Camera: Topcon TRC-NW400 · non-mydriatic acquisition:
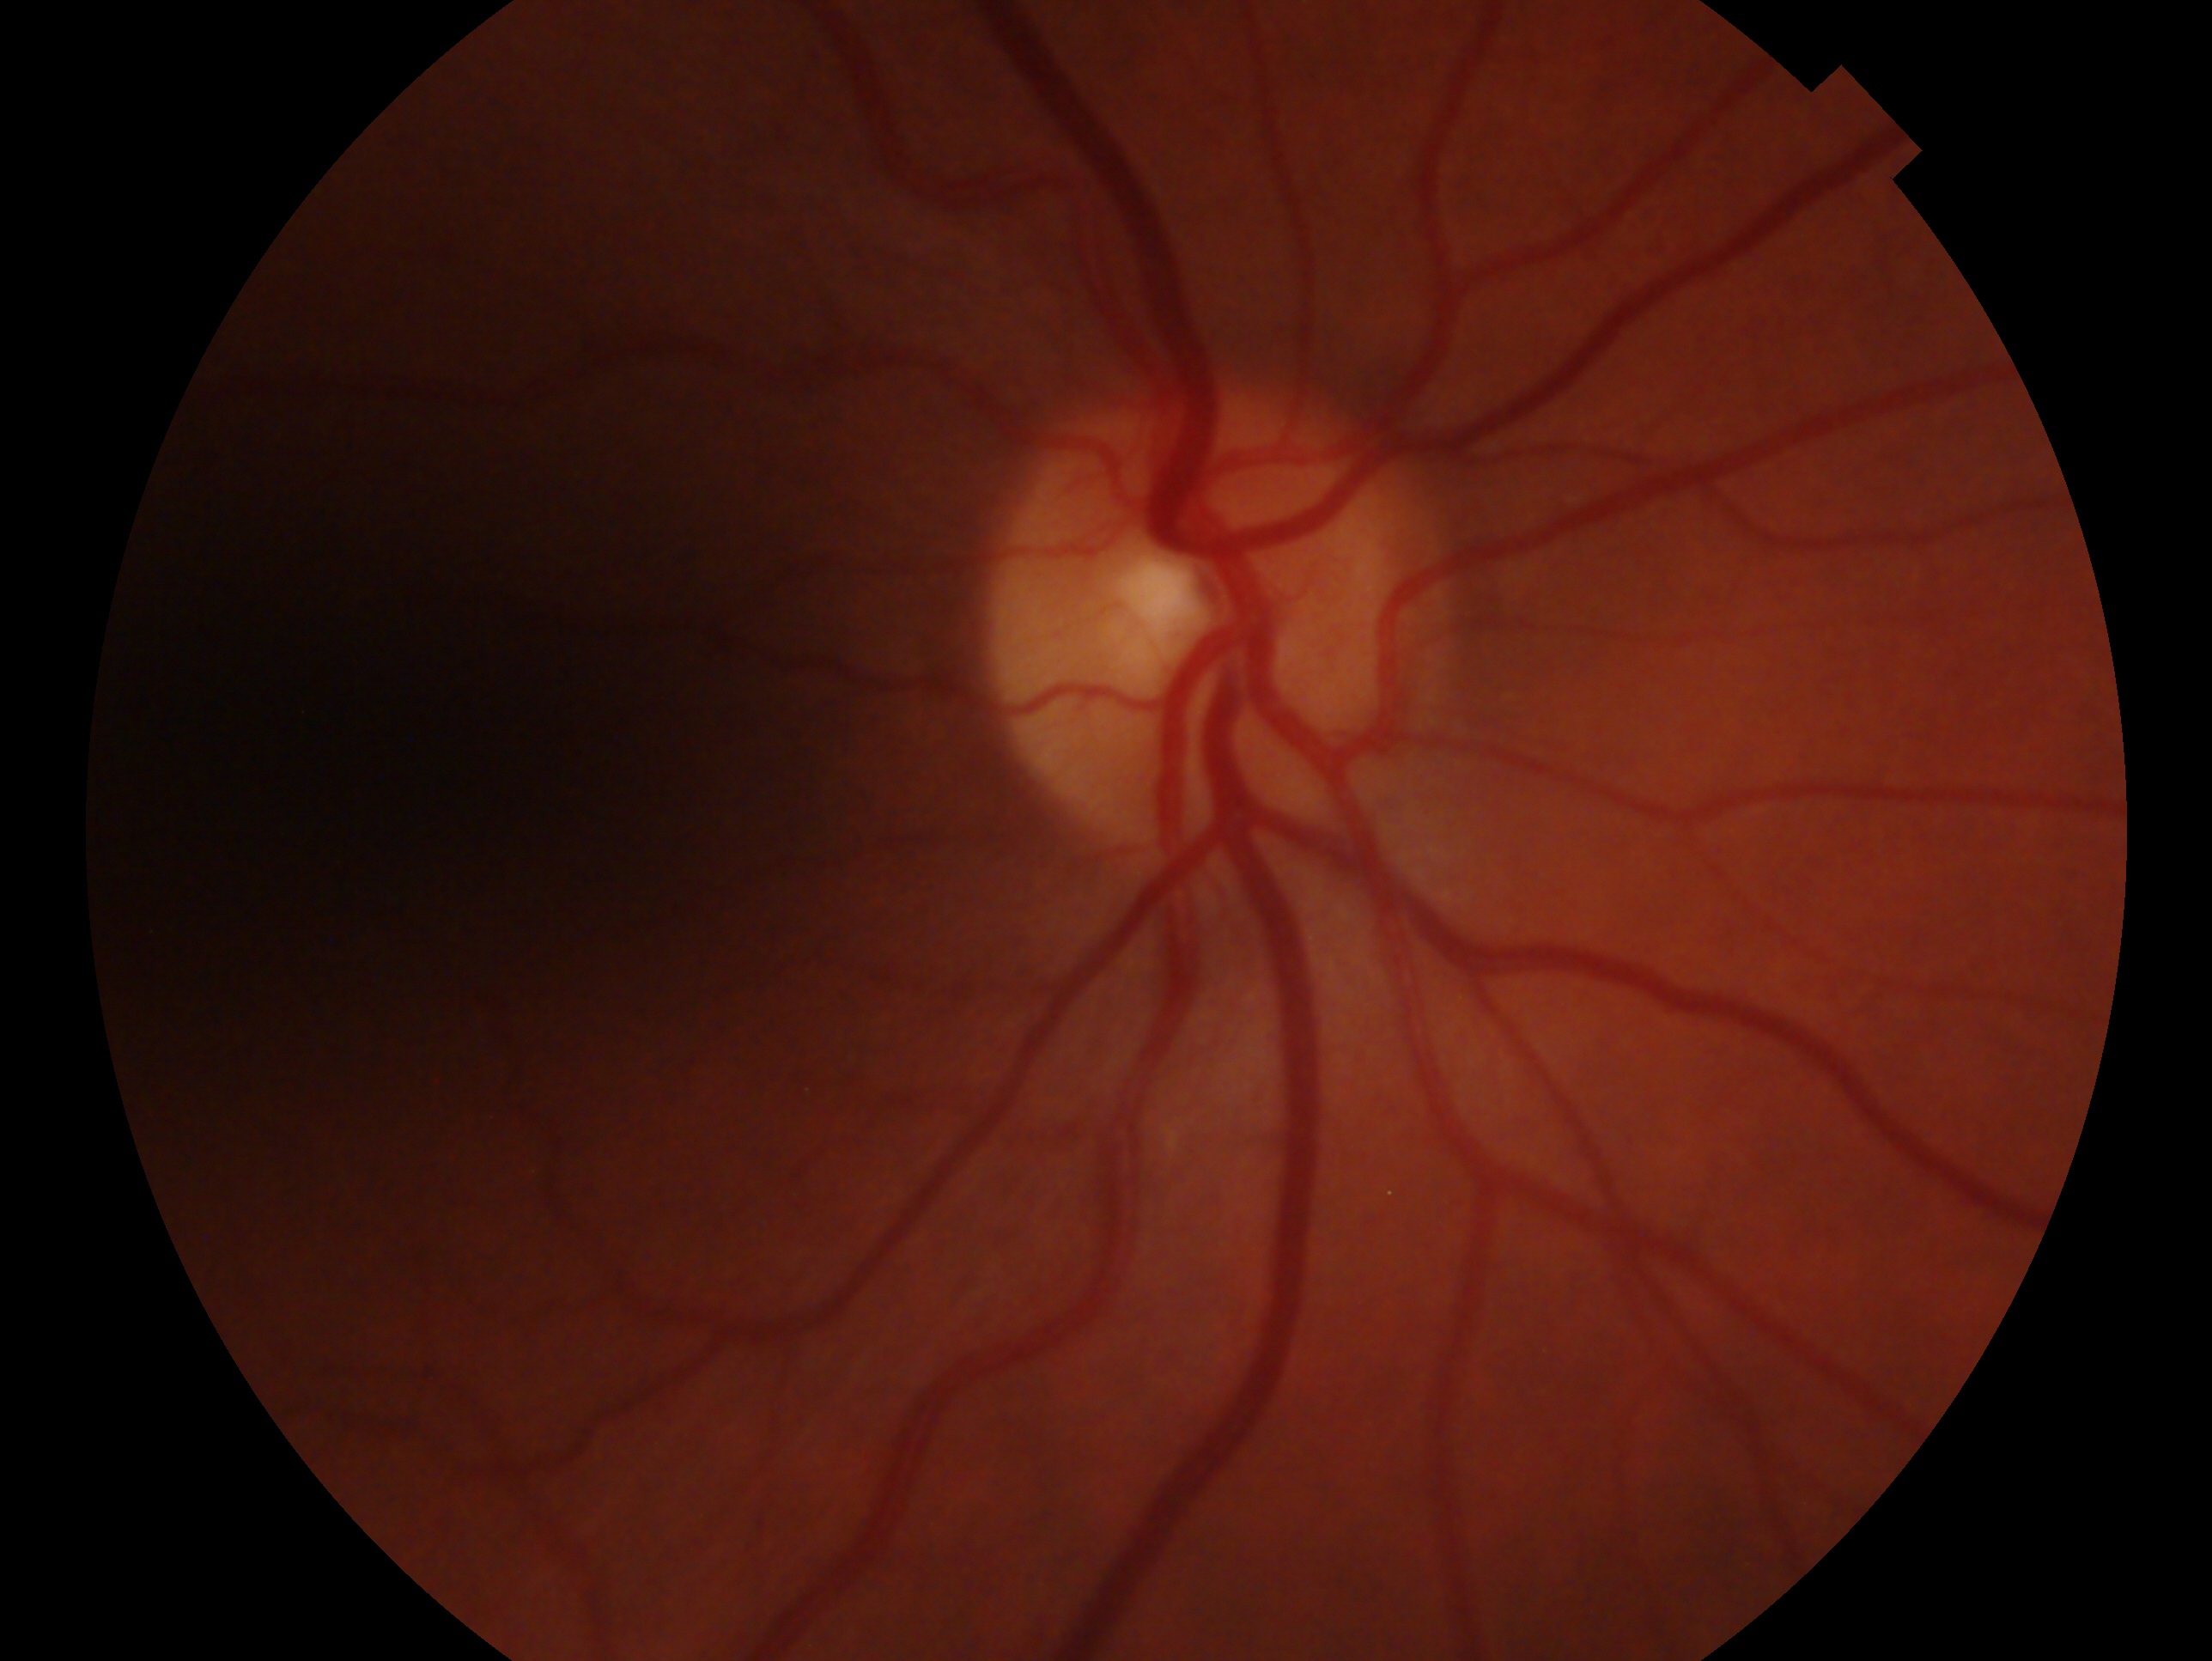
Diagnosis: no glaucoma.
Eye: right.